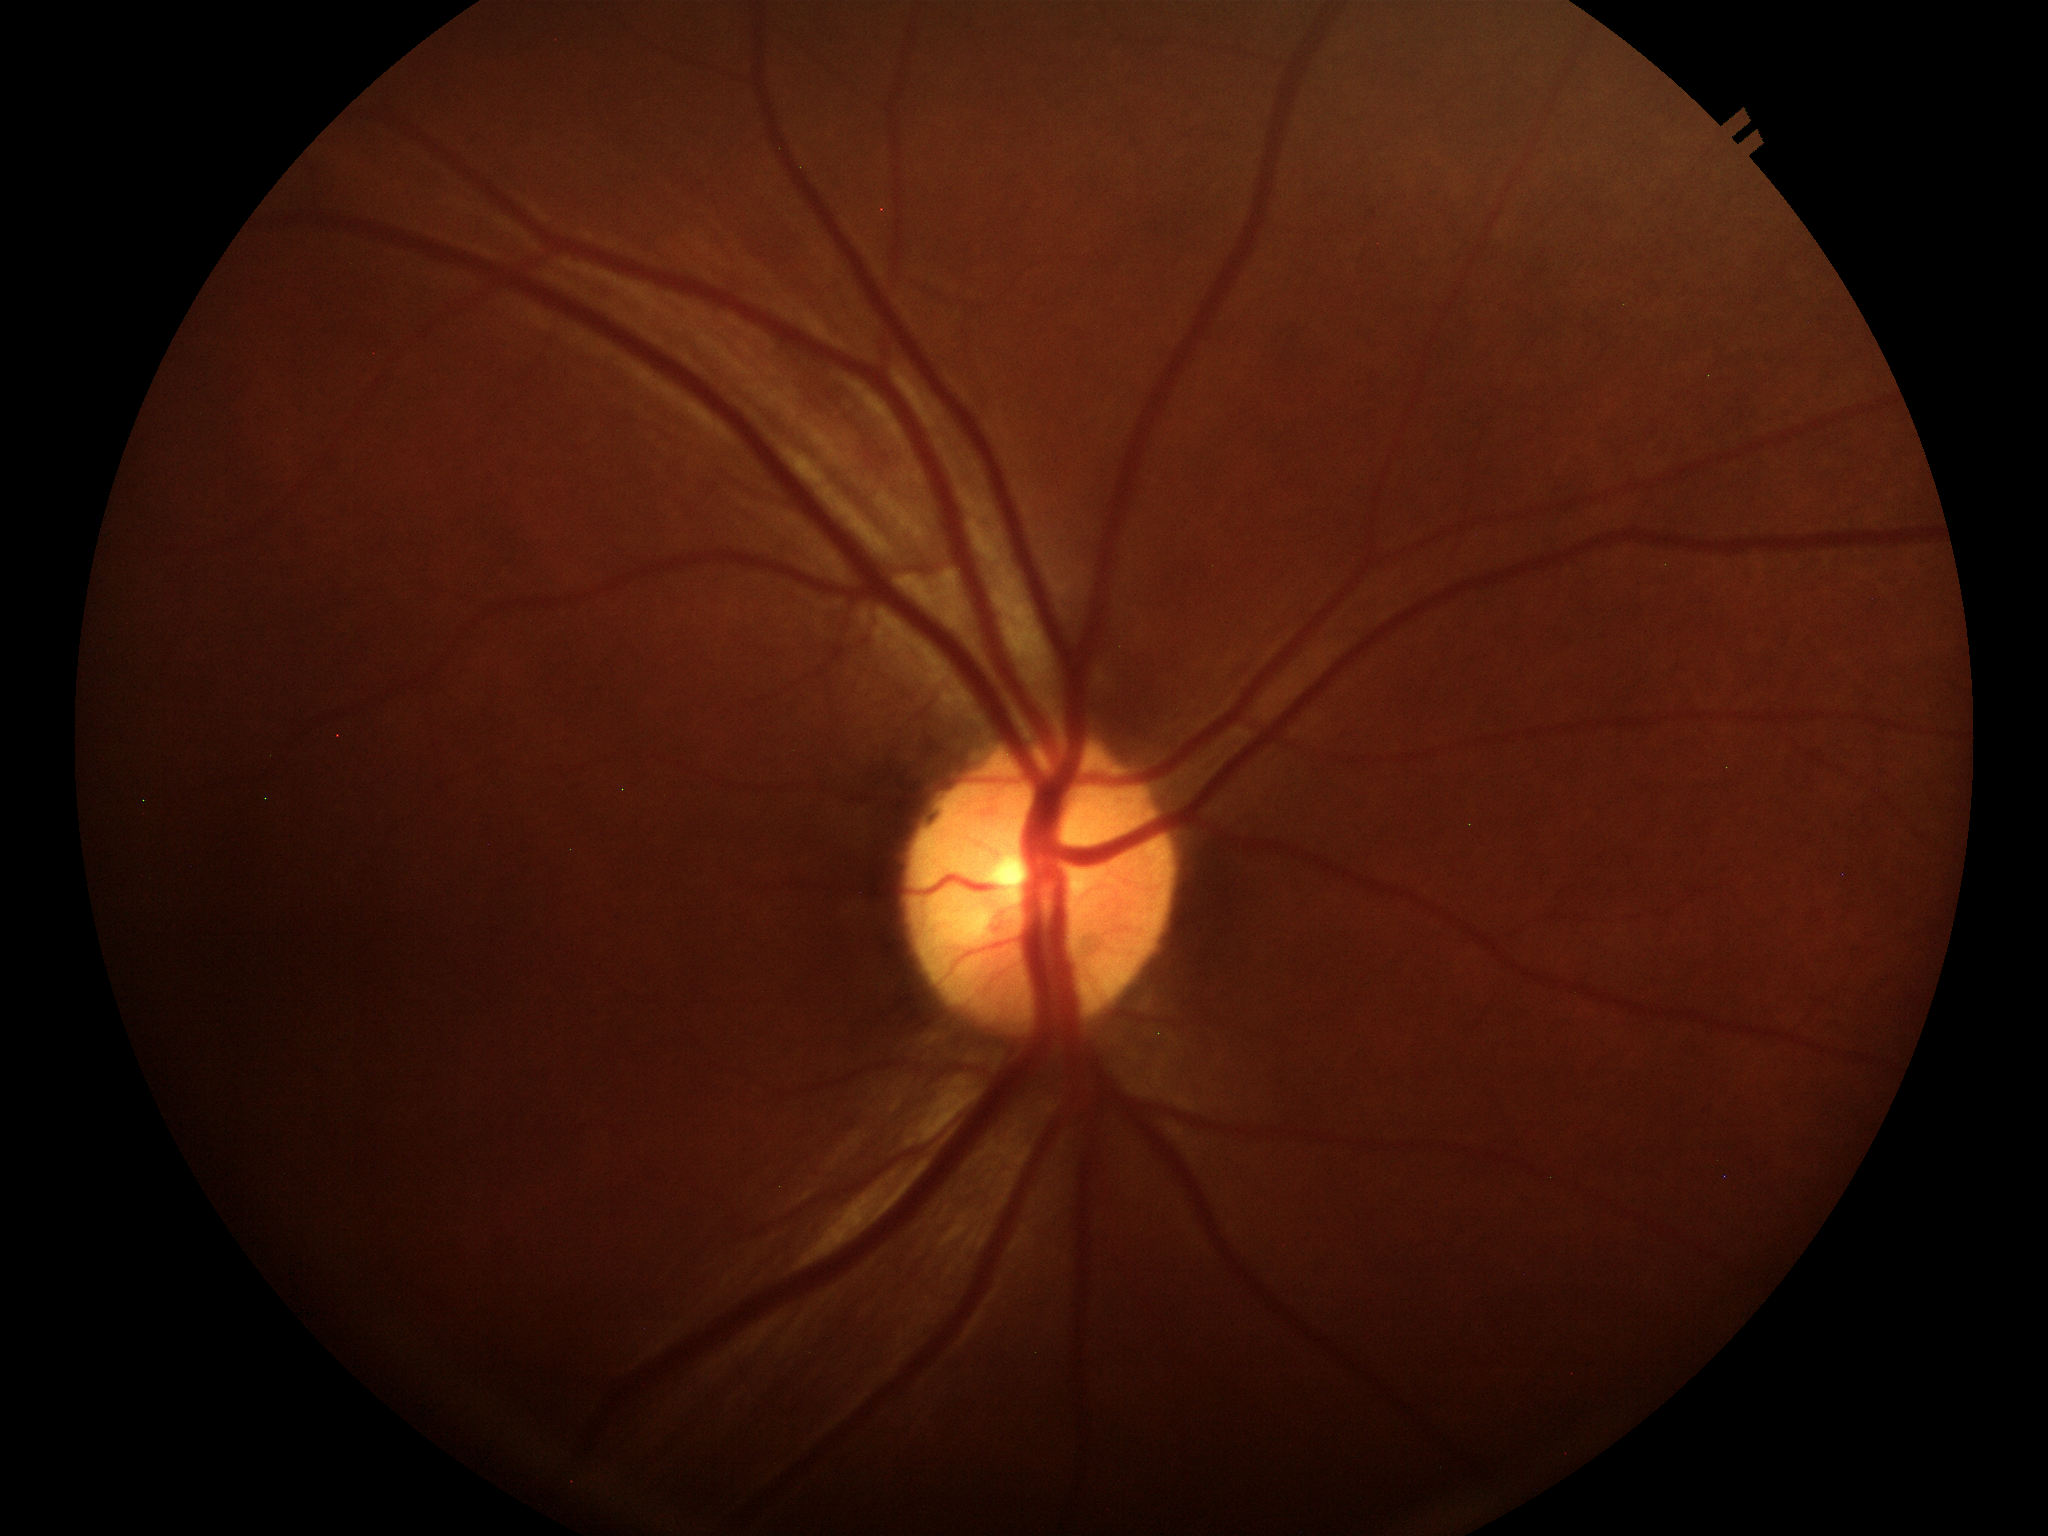
Glaucoma evaluation = not suspect (all 5 graders called normal)
vertical cup-to-disc ratio (VCDR) = 0.48